848x848.
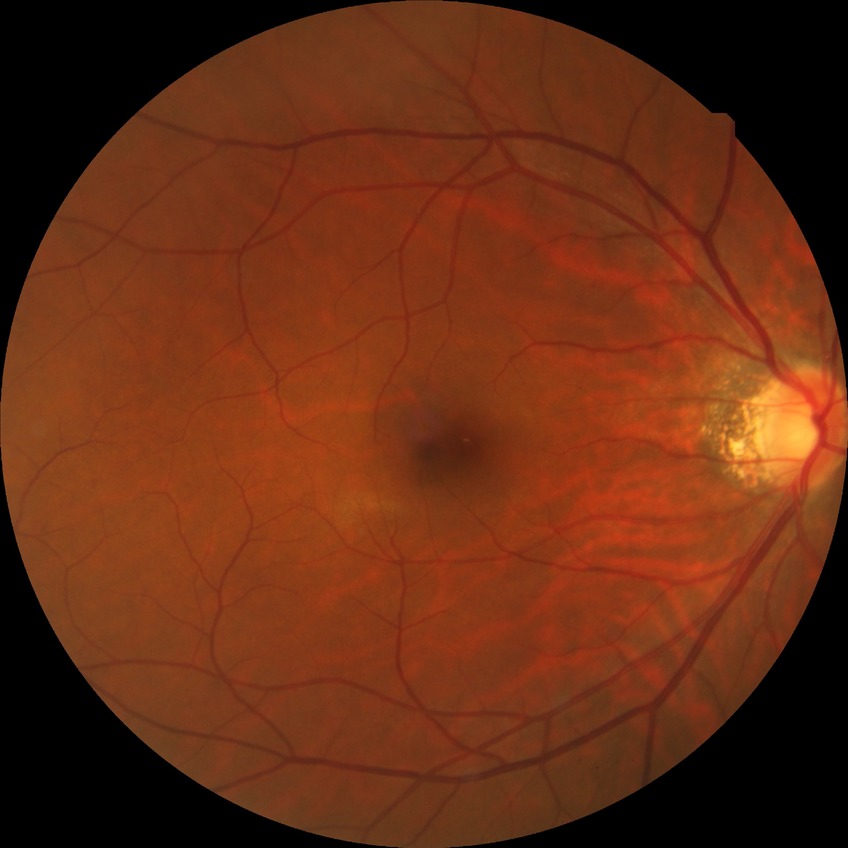

Davis stage: NDR. No apparent diabetic retinopathy.